Wide-field fundus photograph from neonatal ROP screening. Acquired on the Clarity RetCam 3. 640 by 480 pixels
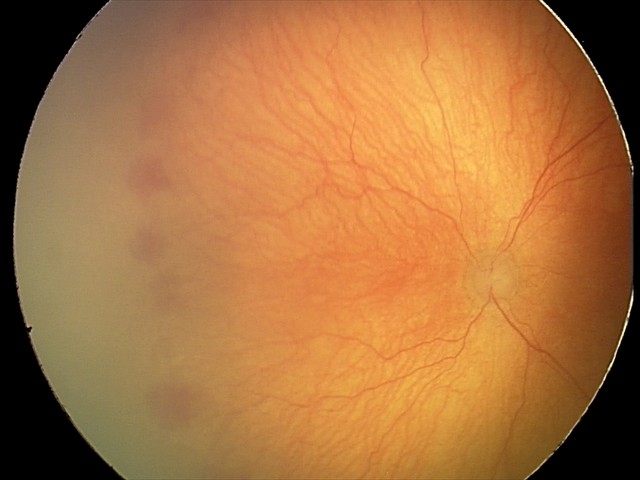
With plus disease.
From an examination with diagnosis of A-ROP (aggressive ROP) — rapidly progressive severe ROP with prominent plus disease, often without classic stage progression.